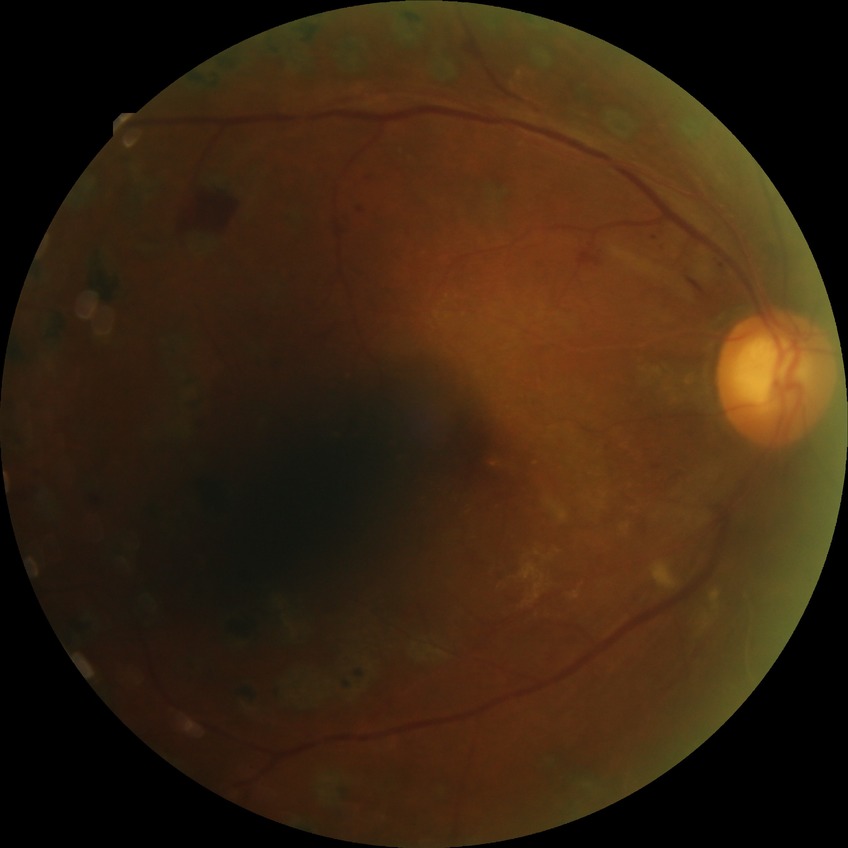
davis_grade: PDR (proliferative diabetic retinopathy)